45-degree field of view; retinal fundus photograph.
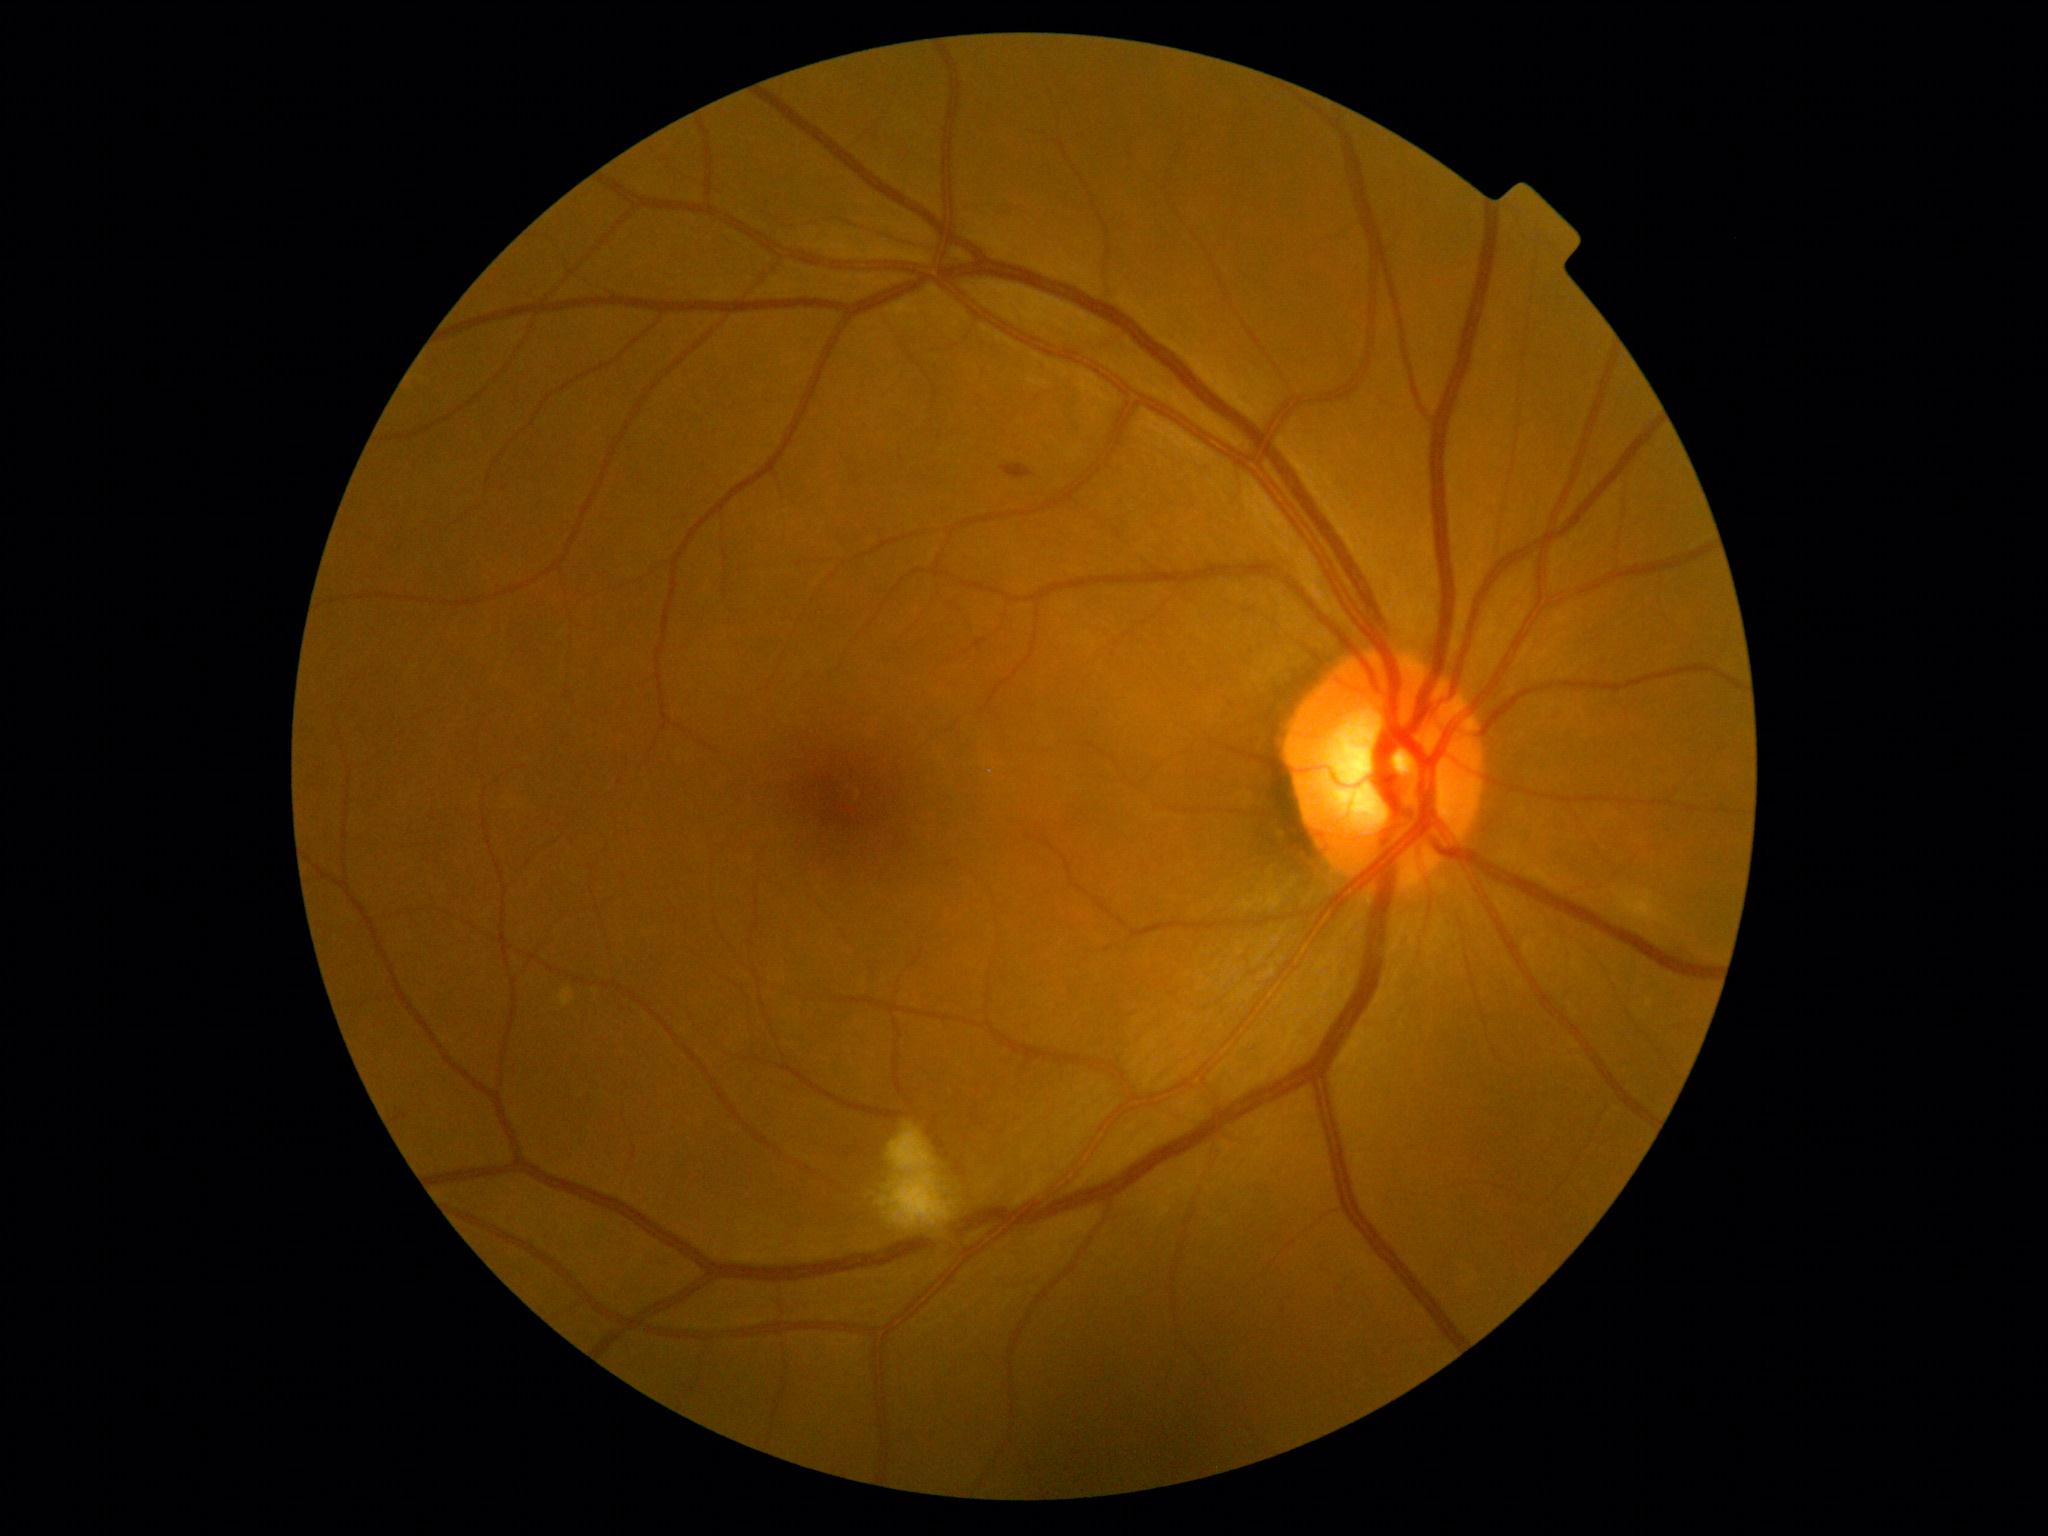
Diabetic retinopathy: moderate non-proliferative diabetic retinopathy (grade 2). Soft exudates located at box(881, 1123, 952, 1231). Hemorrhages located at box(935, 1136, 947, 1151); box(954, 1162, 967, 1176); box(1001, 465, 1034, 481). Additional small hemorrhages near 948, 1156. No hard exudates identified. No microaneurysms identified.